45-degree field of view — 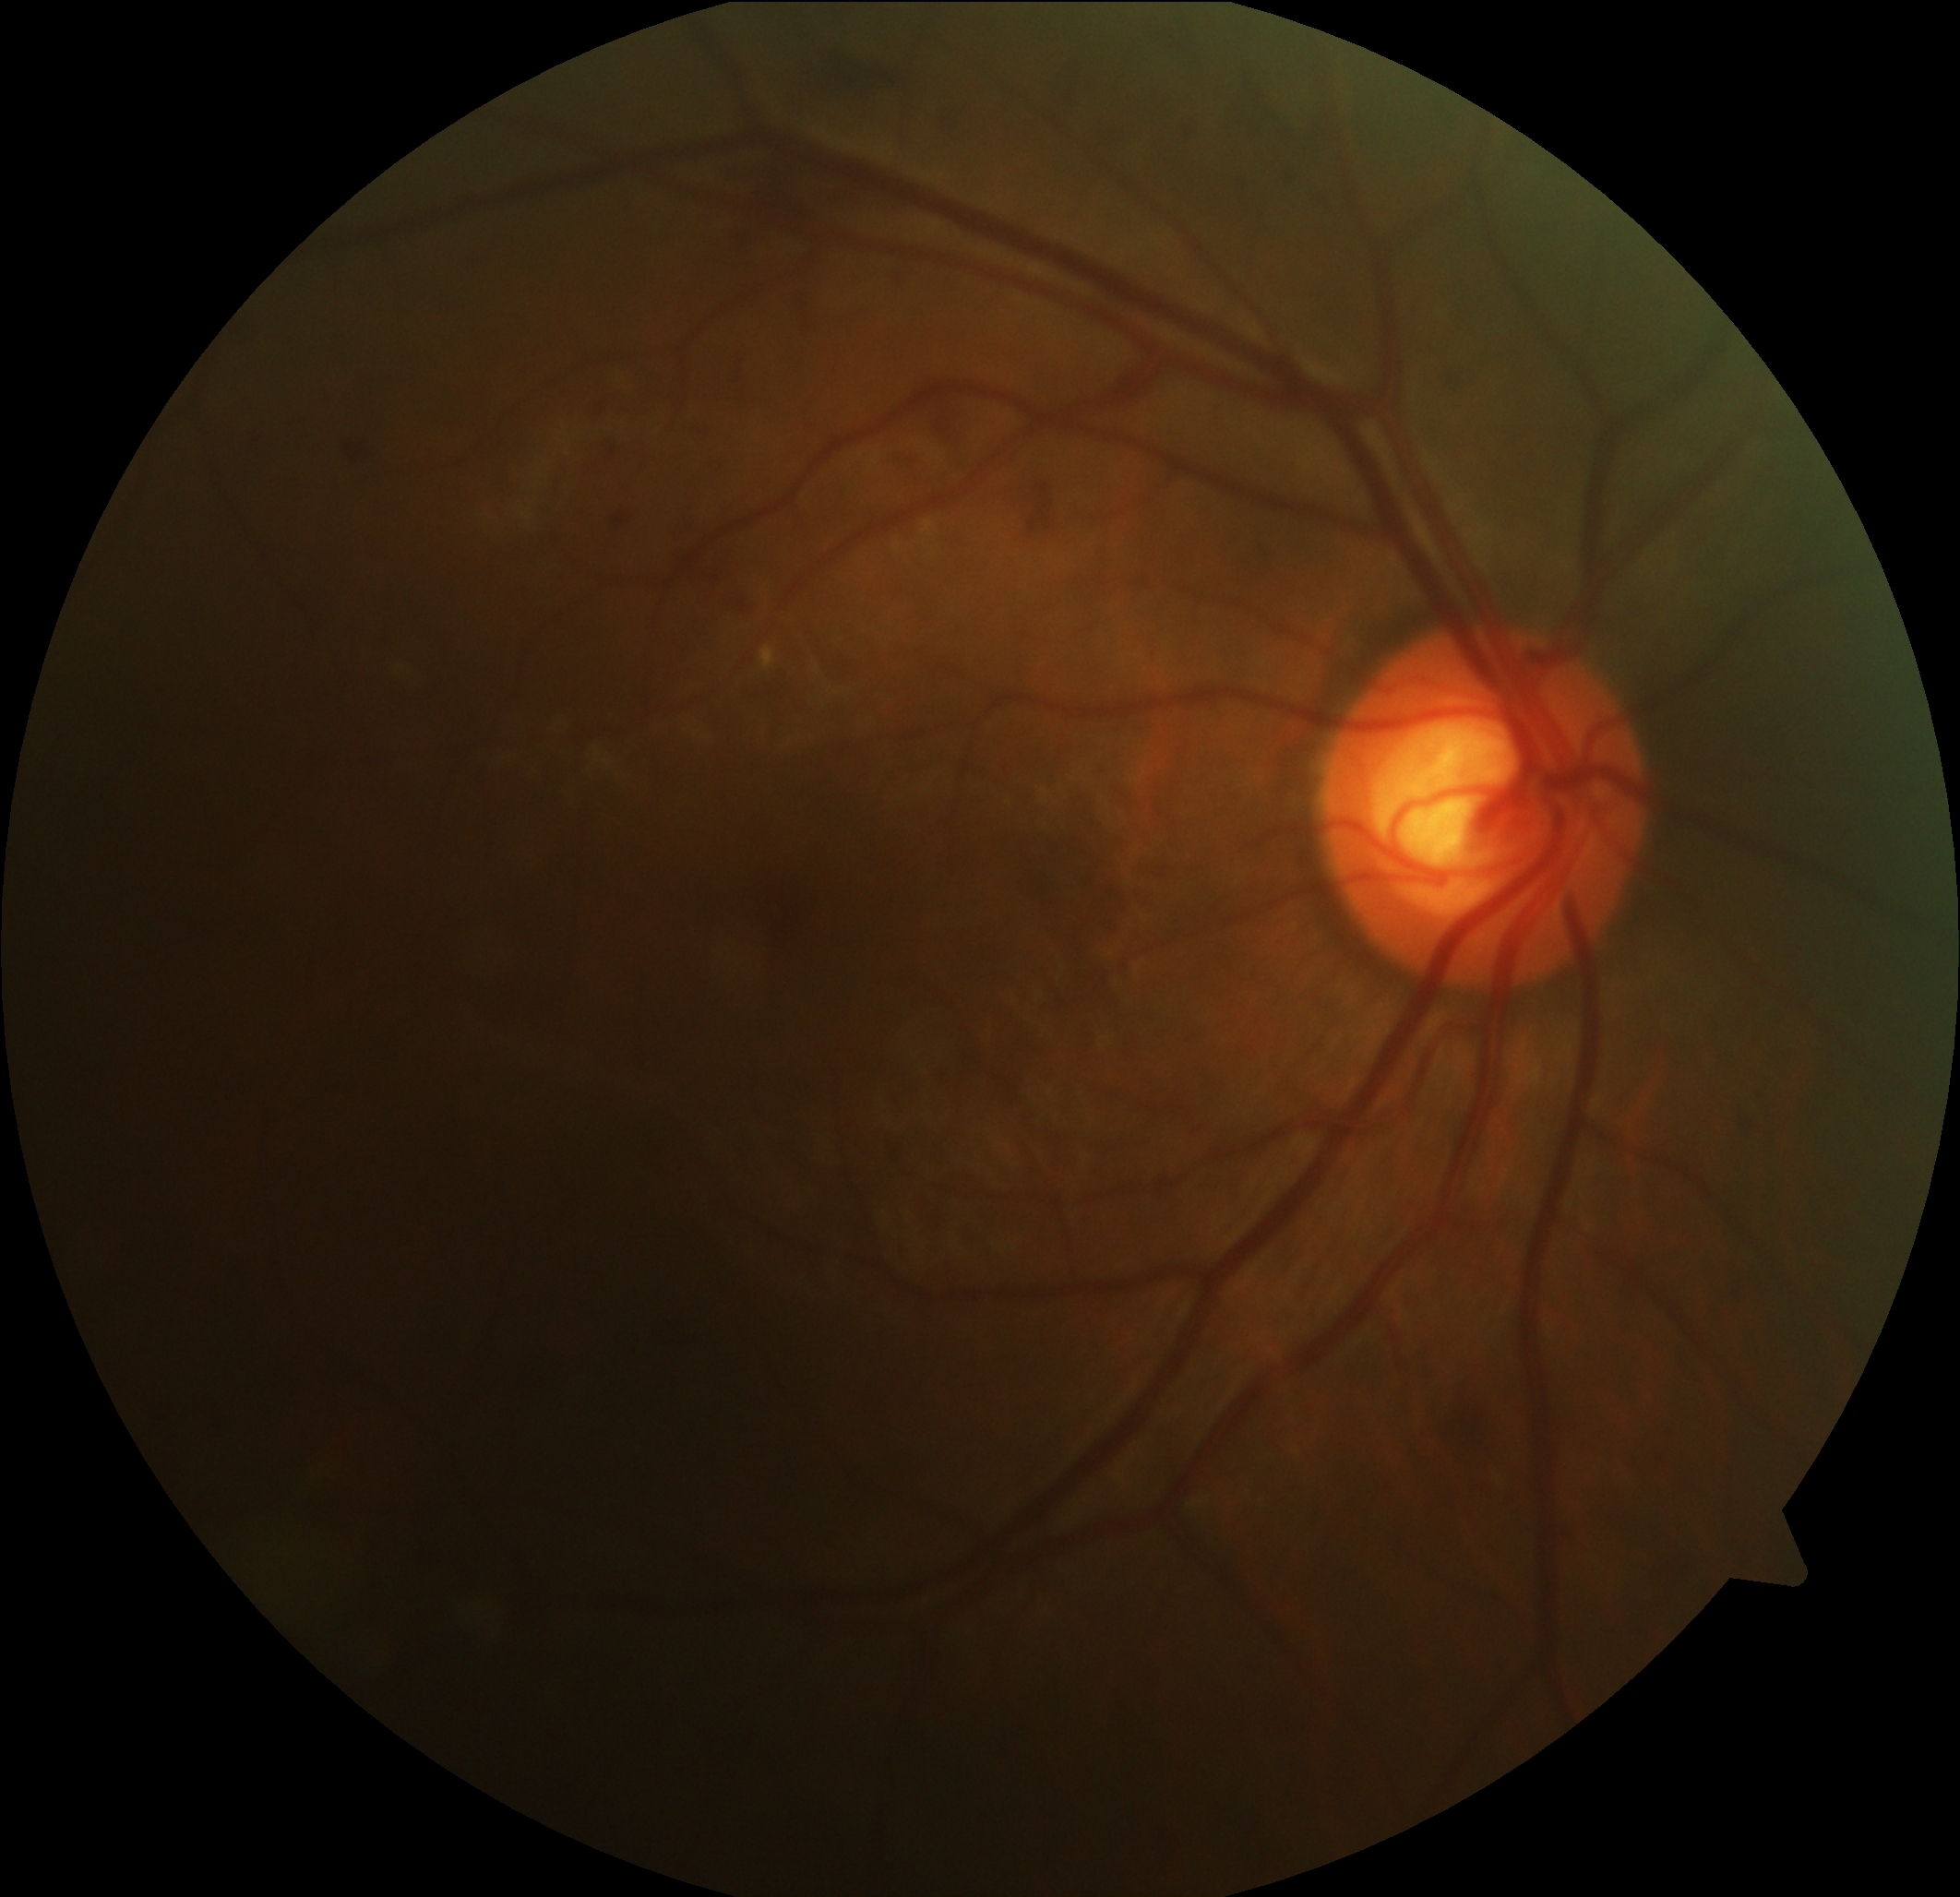 DR grade: 2 — more than just microaneurysms but less than severe NPDR.